Wide-field contact fundus photograph of an infant:
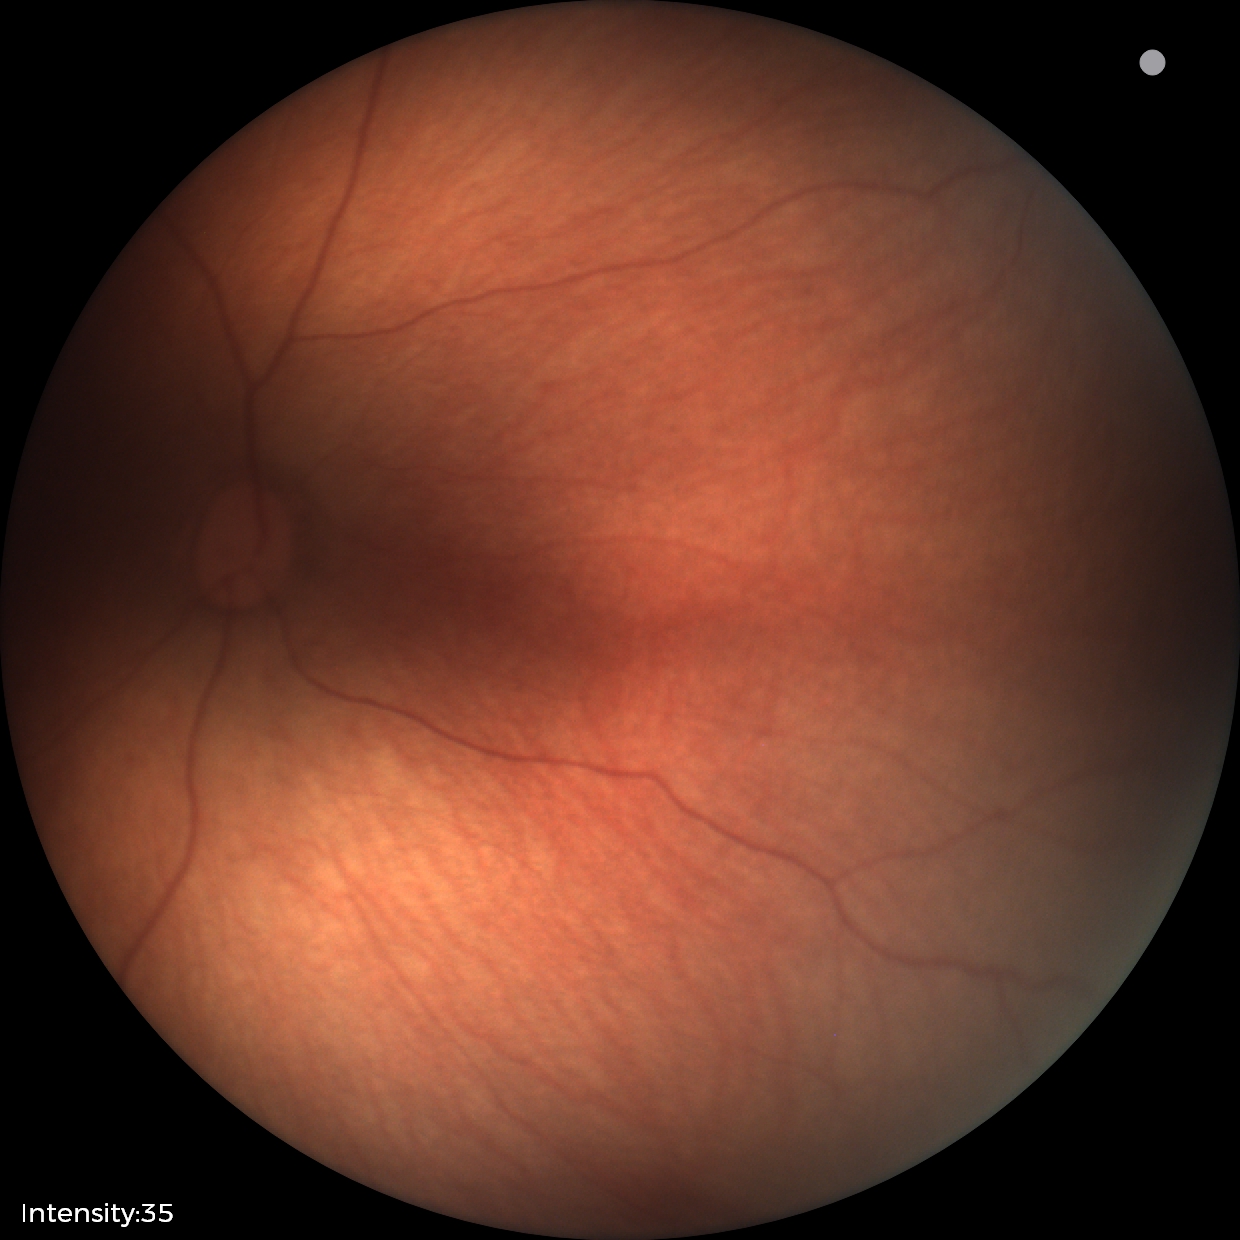

Normal screening examination.